Optic disc at the center of the field; visual field mean defect (MD): -1.05 dB; captured on a Topcon TRC-NW400 fundus camera; 30° FOV; axial length (AL) 22.6 mm: 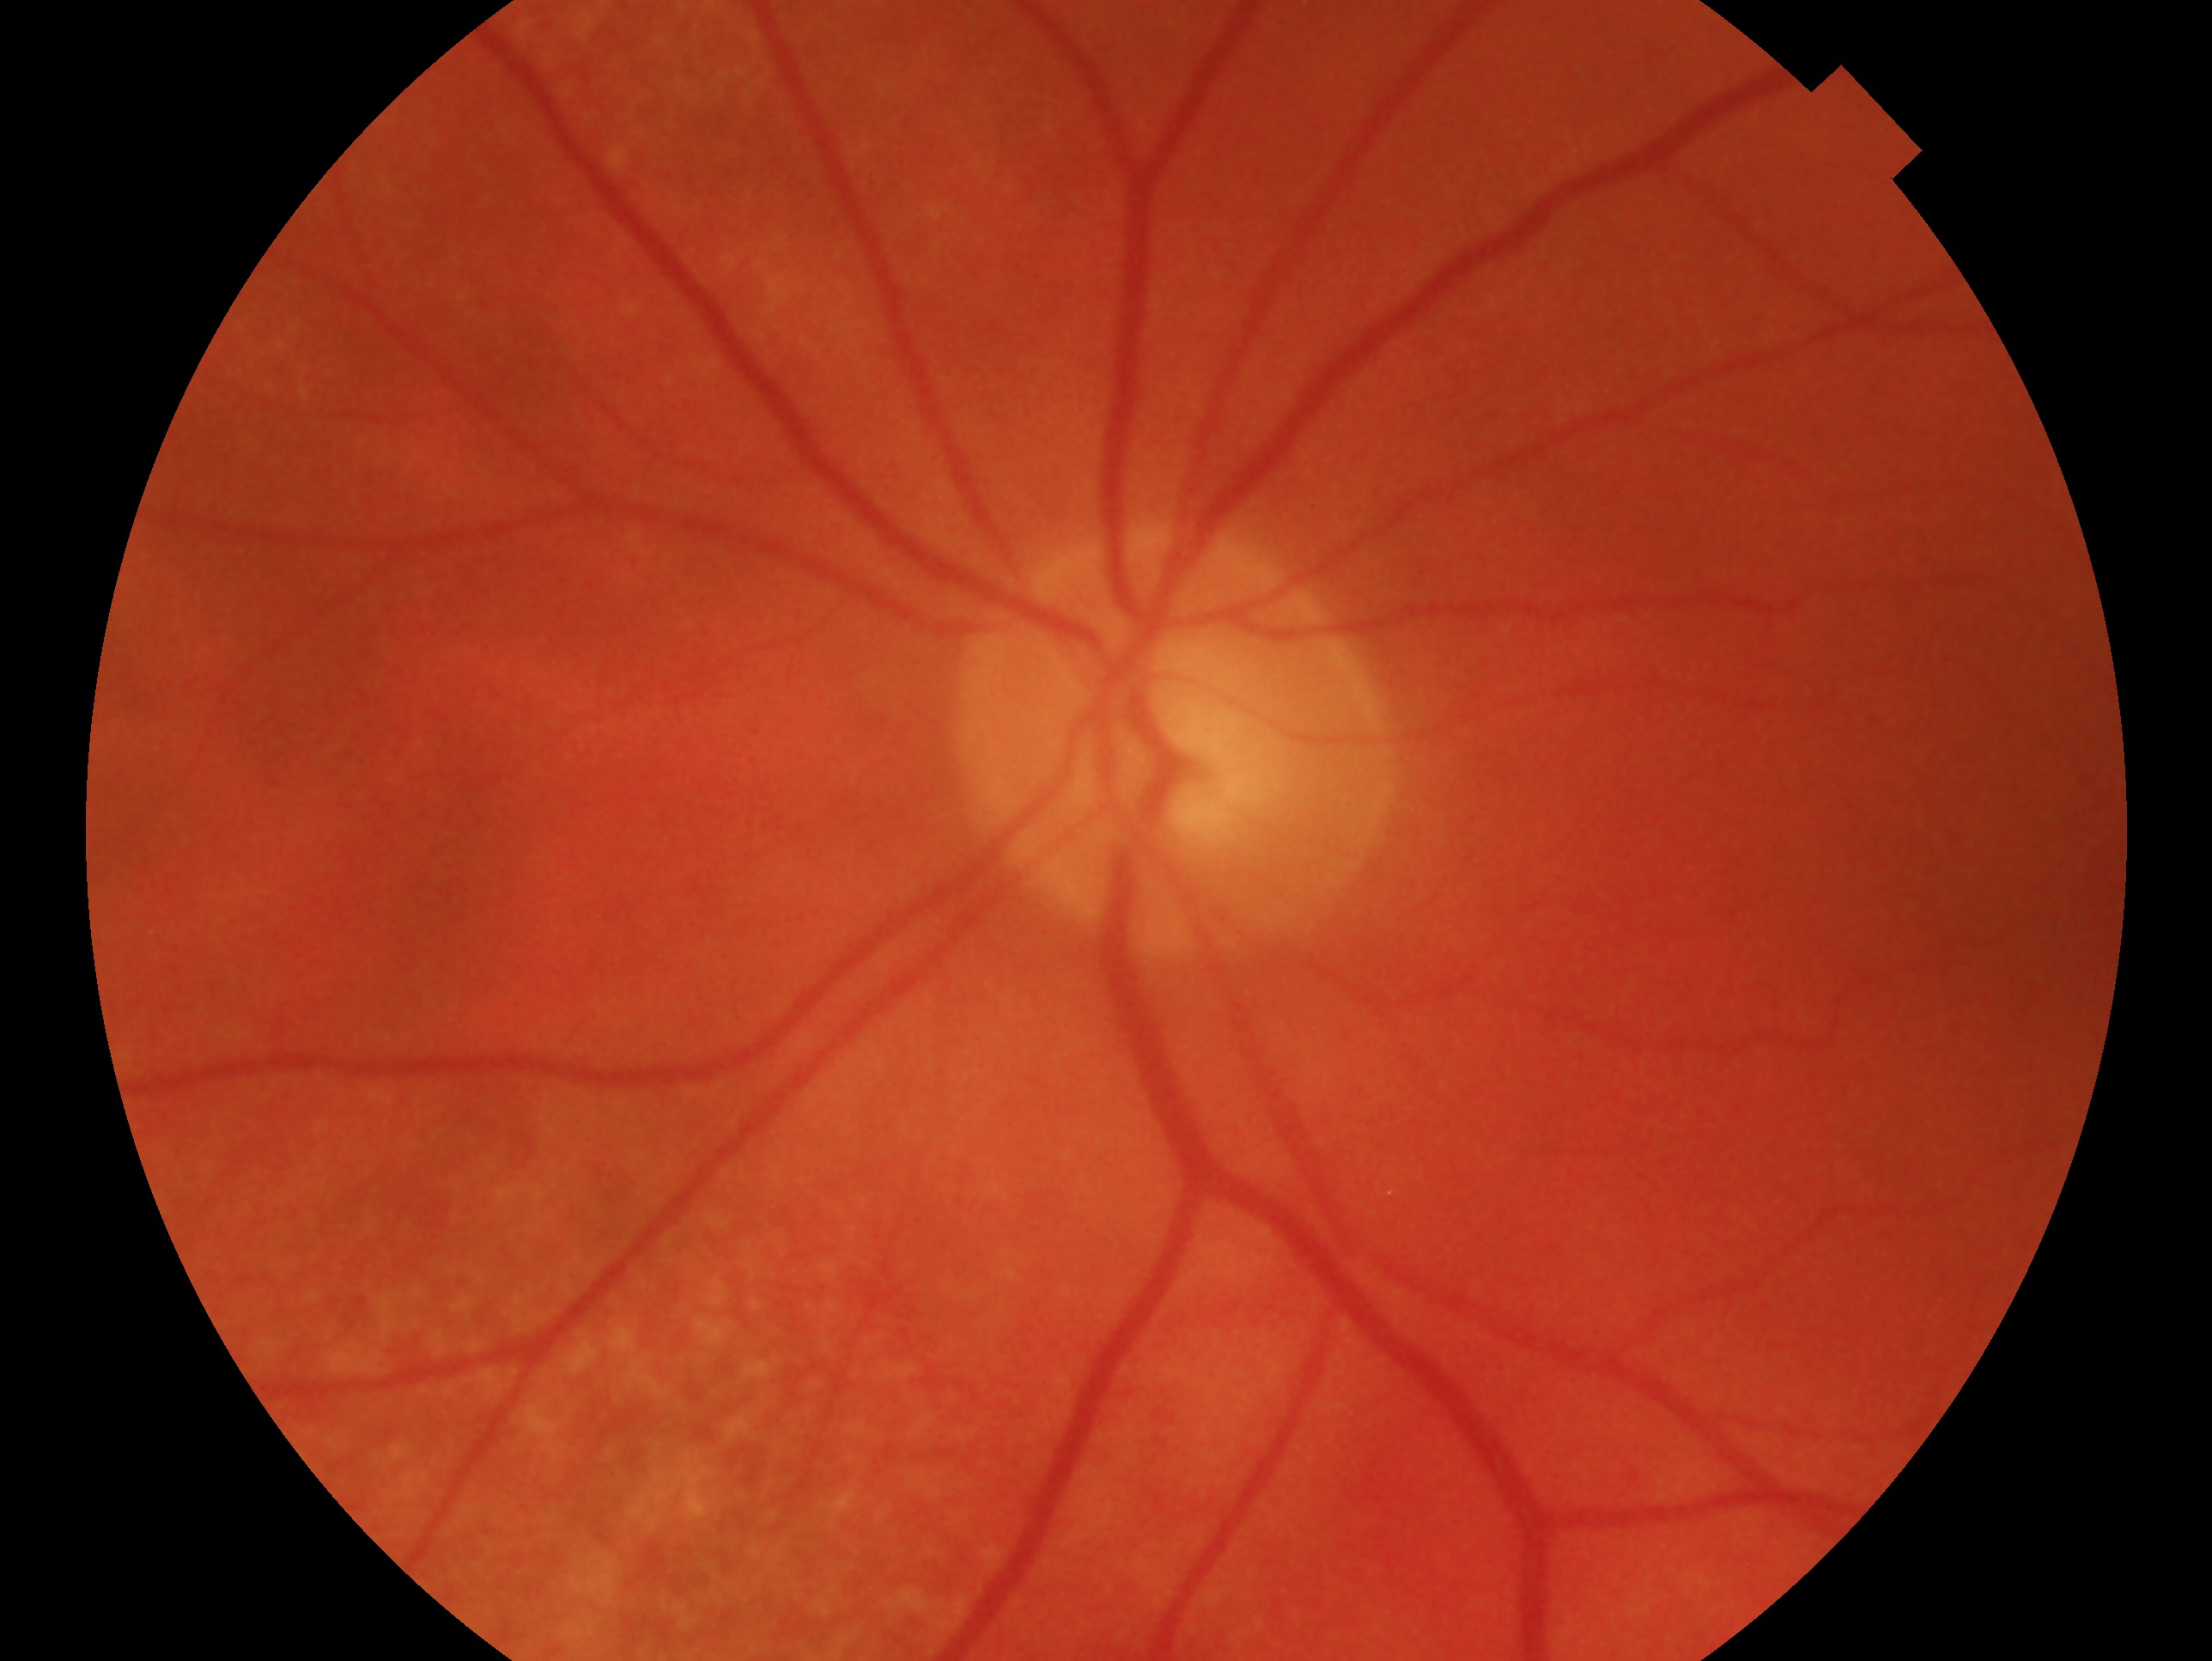

{"eye": "left eye", "glaucoma_dx": "glaucomatous optic neuropathy"}